1440x1080px · wide-field fundus photograph of an infant
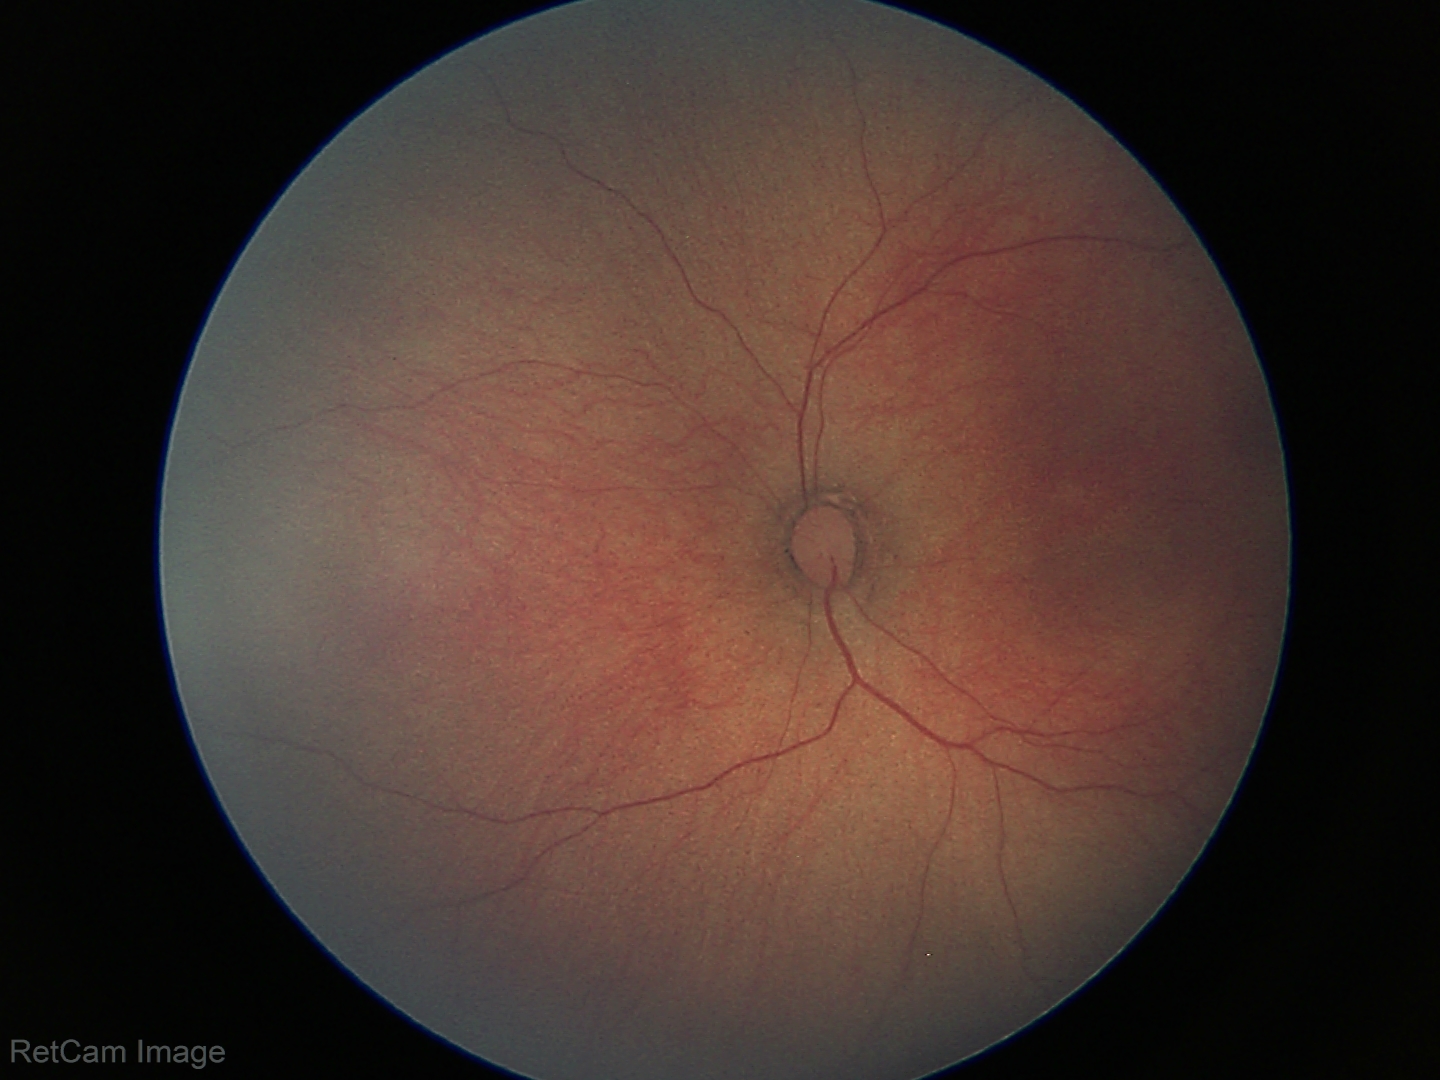
Assessment = normal retinal appearance.